45-degree field of view. Retinal fundus photograph — 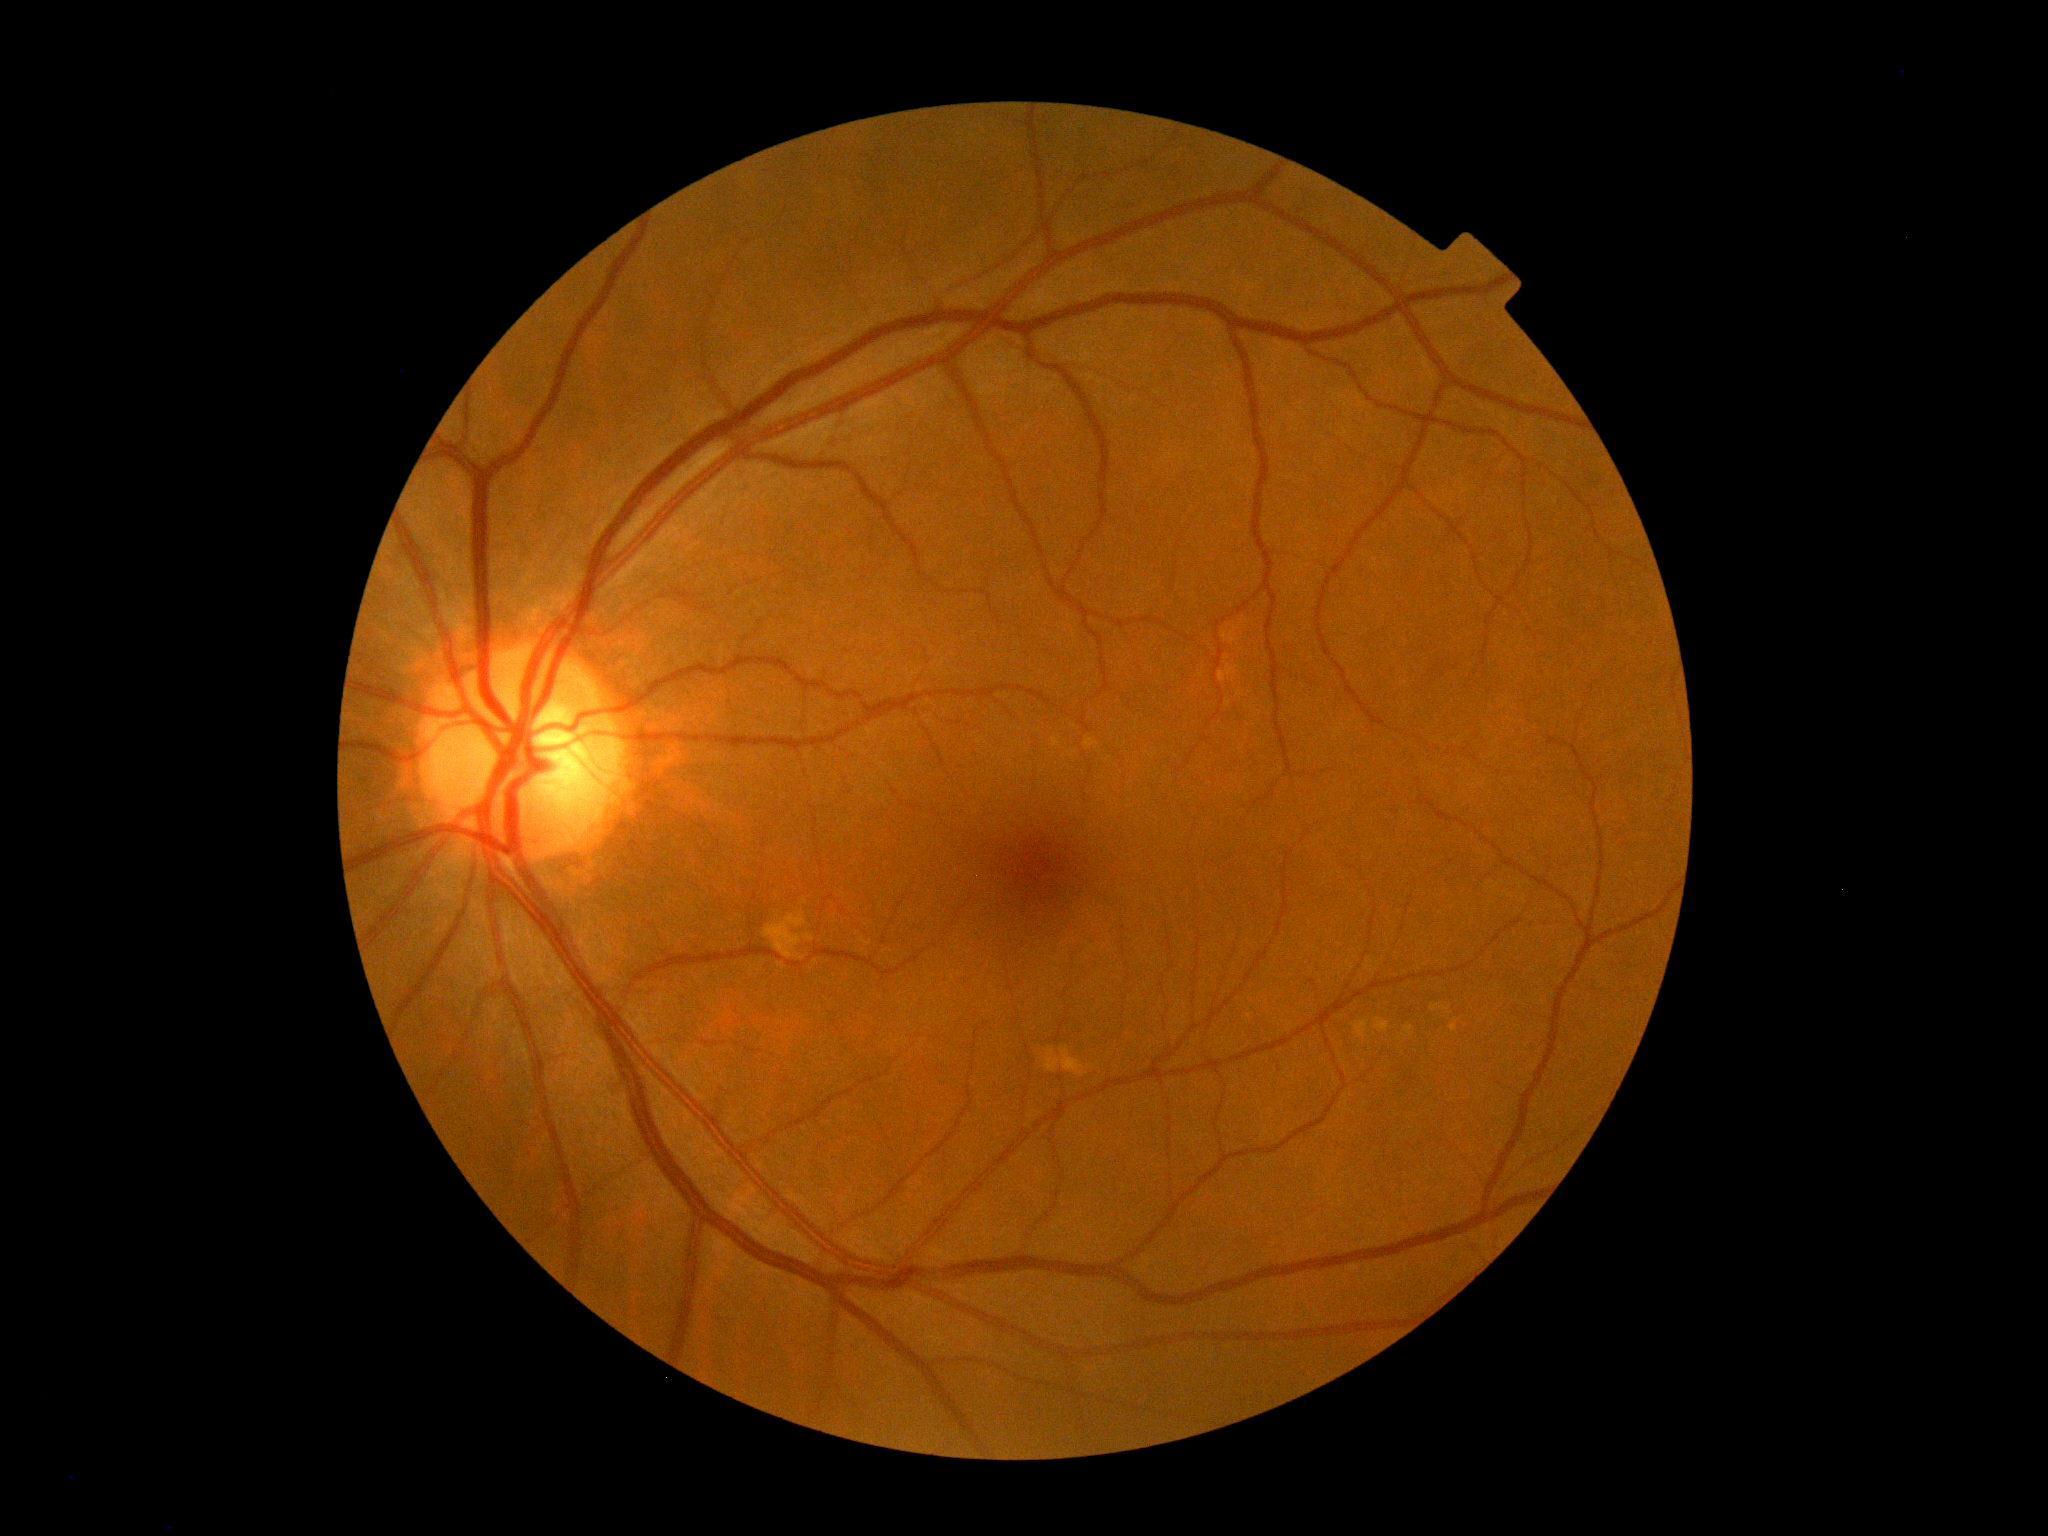
DR impression@negative for DR; diabetic retinopathy (DR)@no apparent diabetic retinopathy (grade 0).